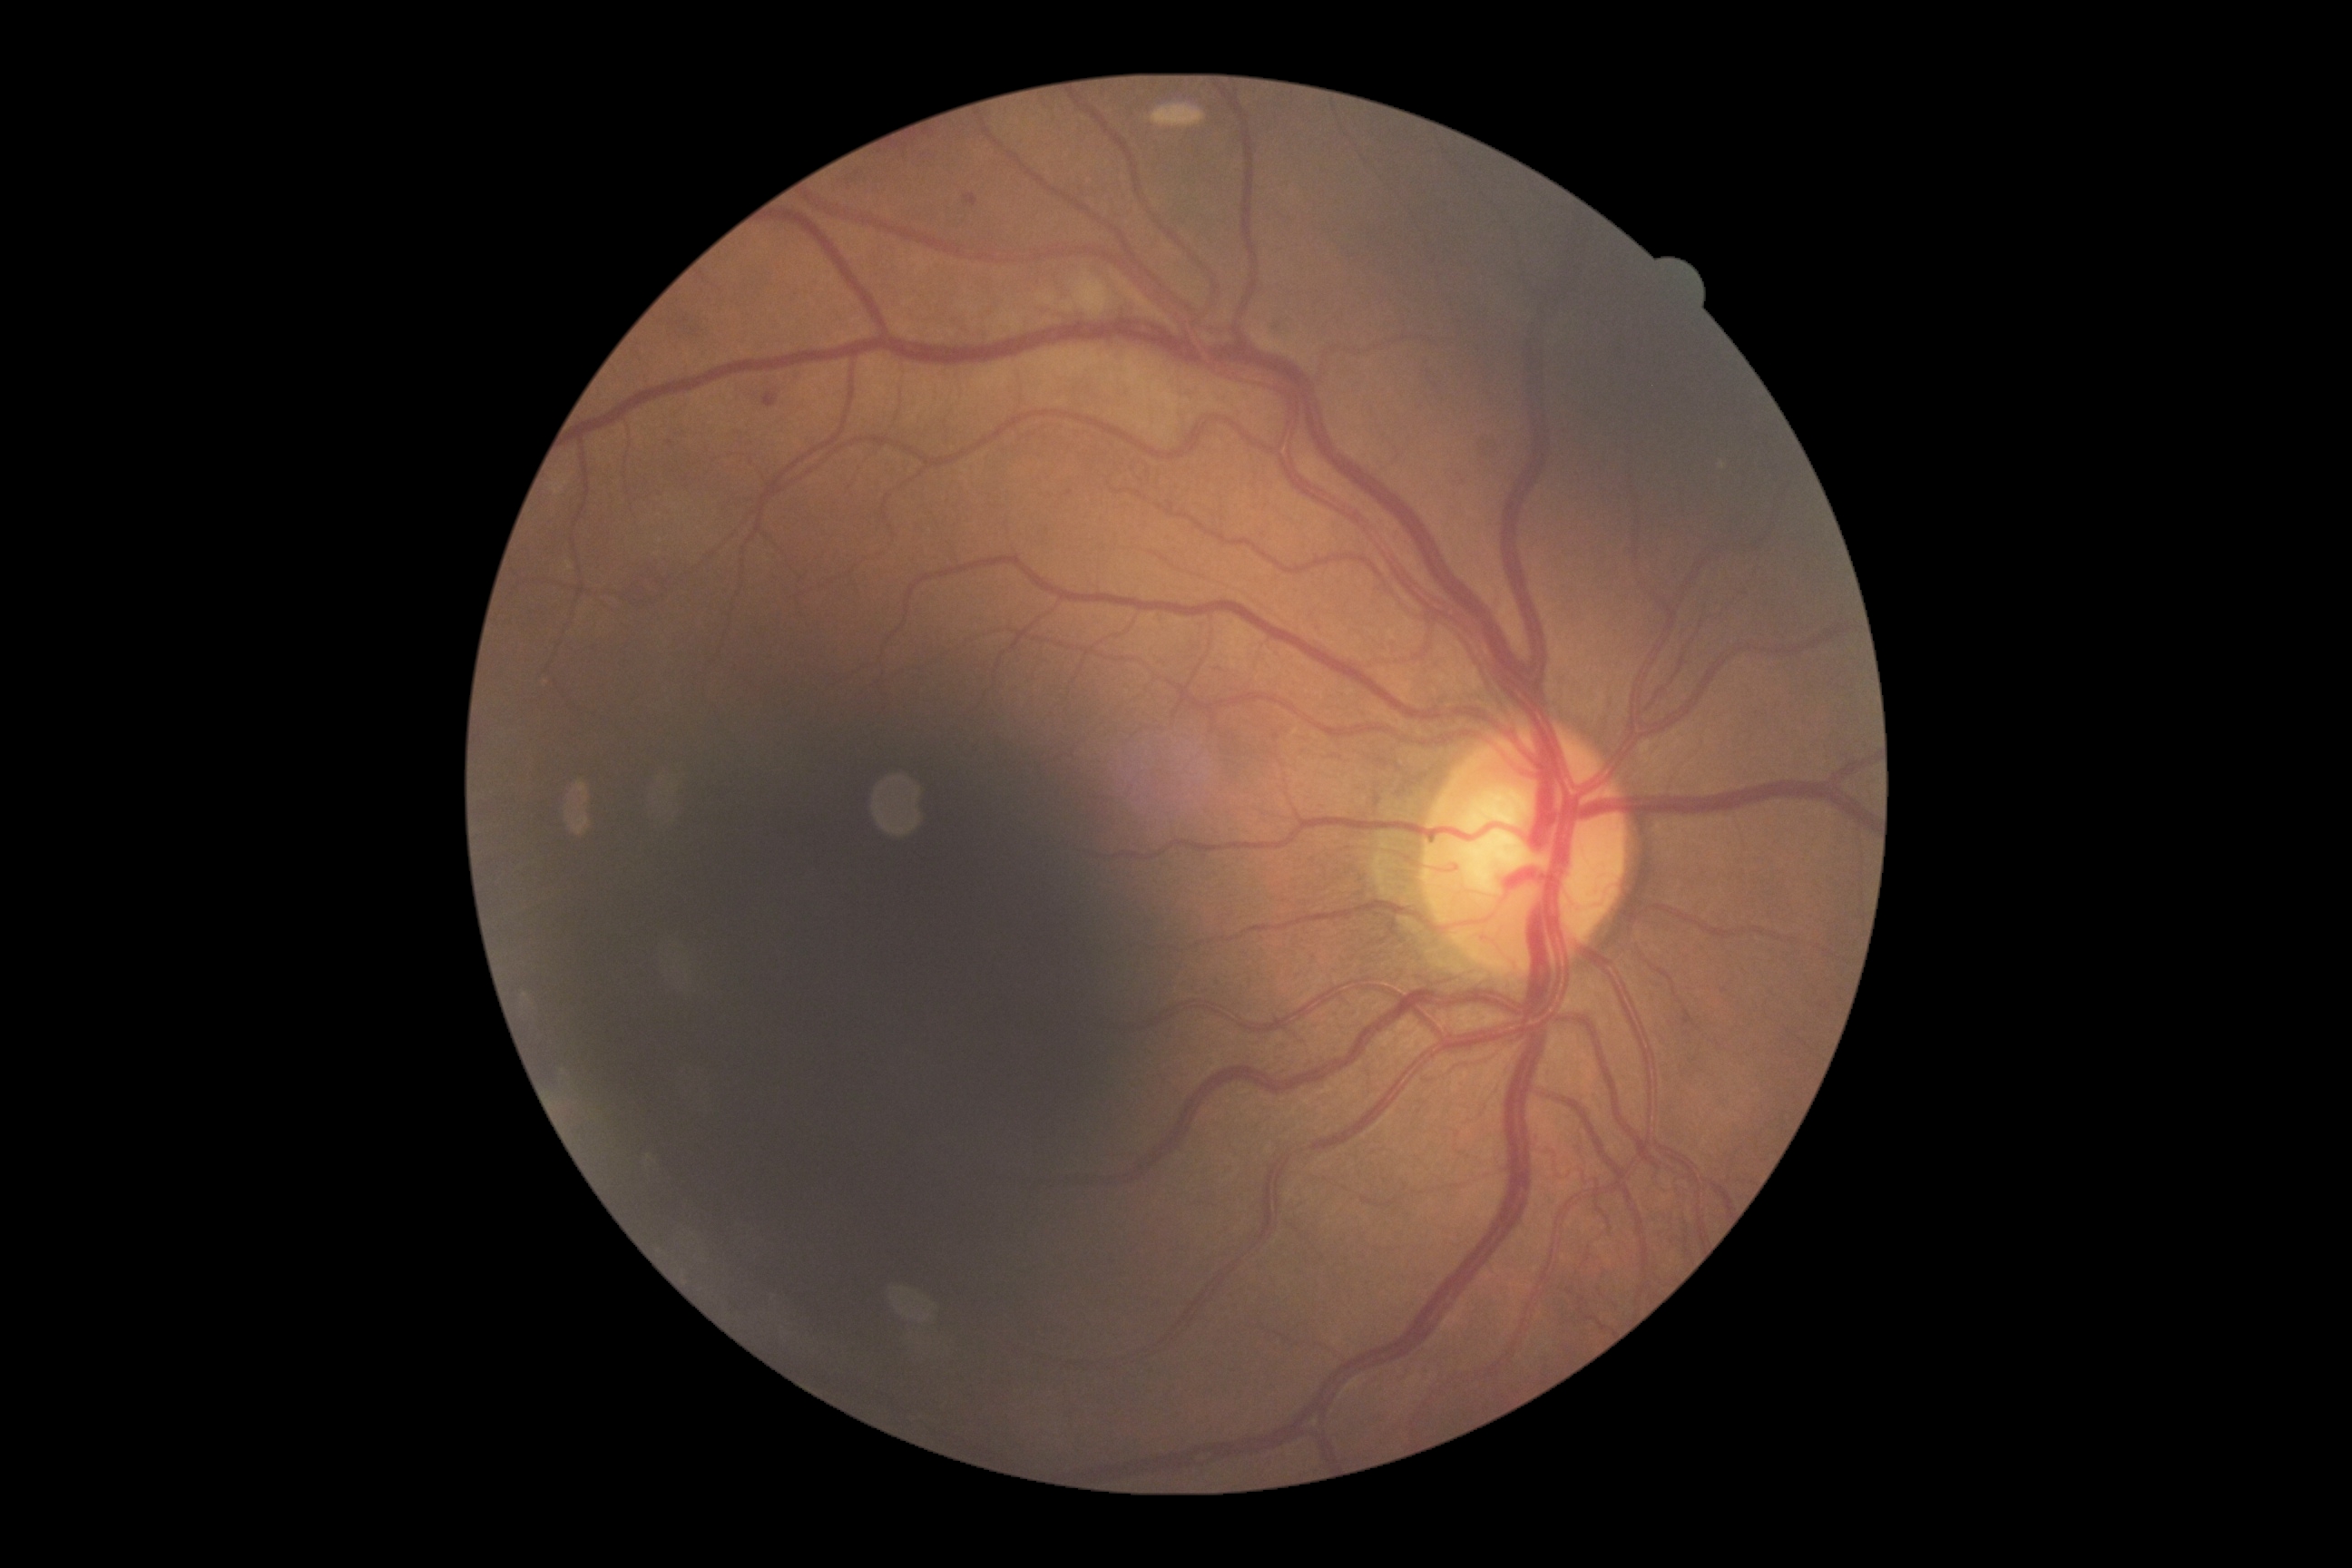

DR grade: moderate NPDR (2).